Retinal fundus photograph: 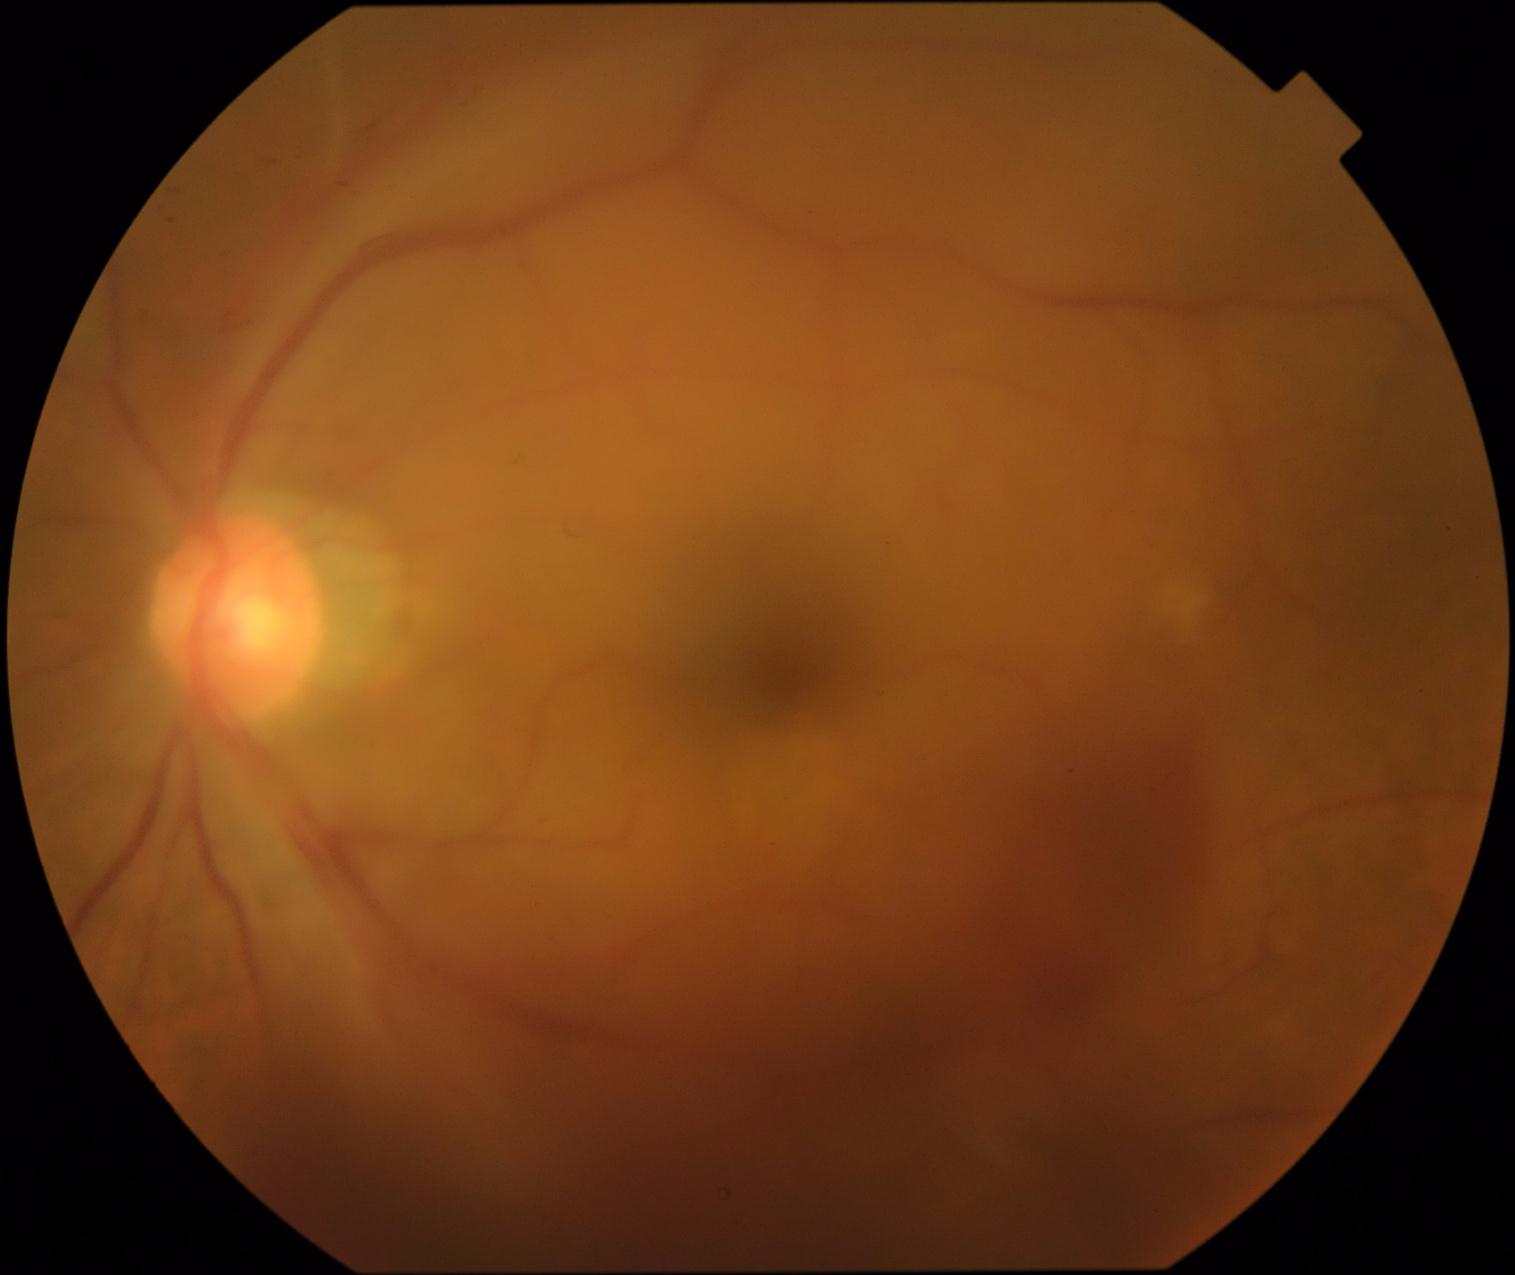
Disease class: proliferative diabetic retinopathy. Diabetic retinopathy grade is 4.